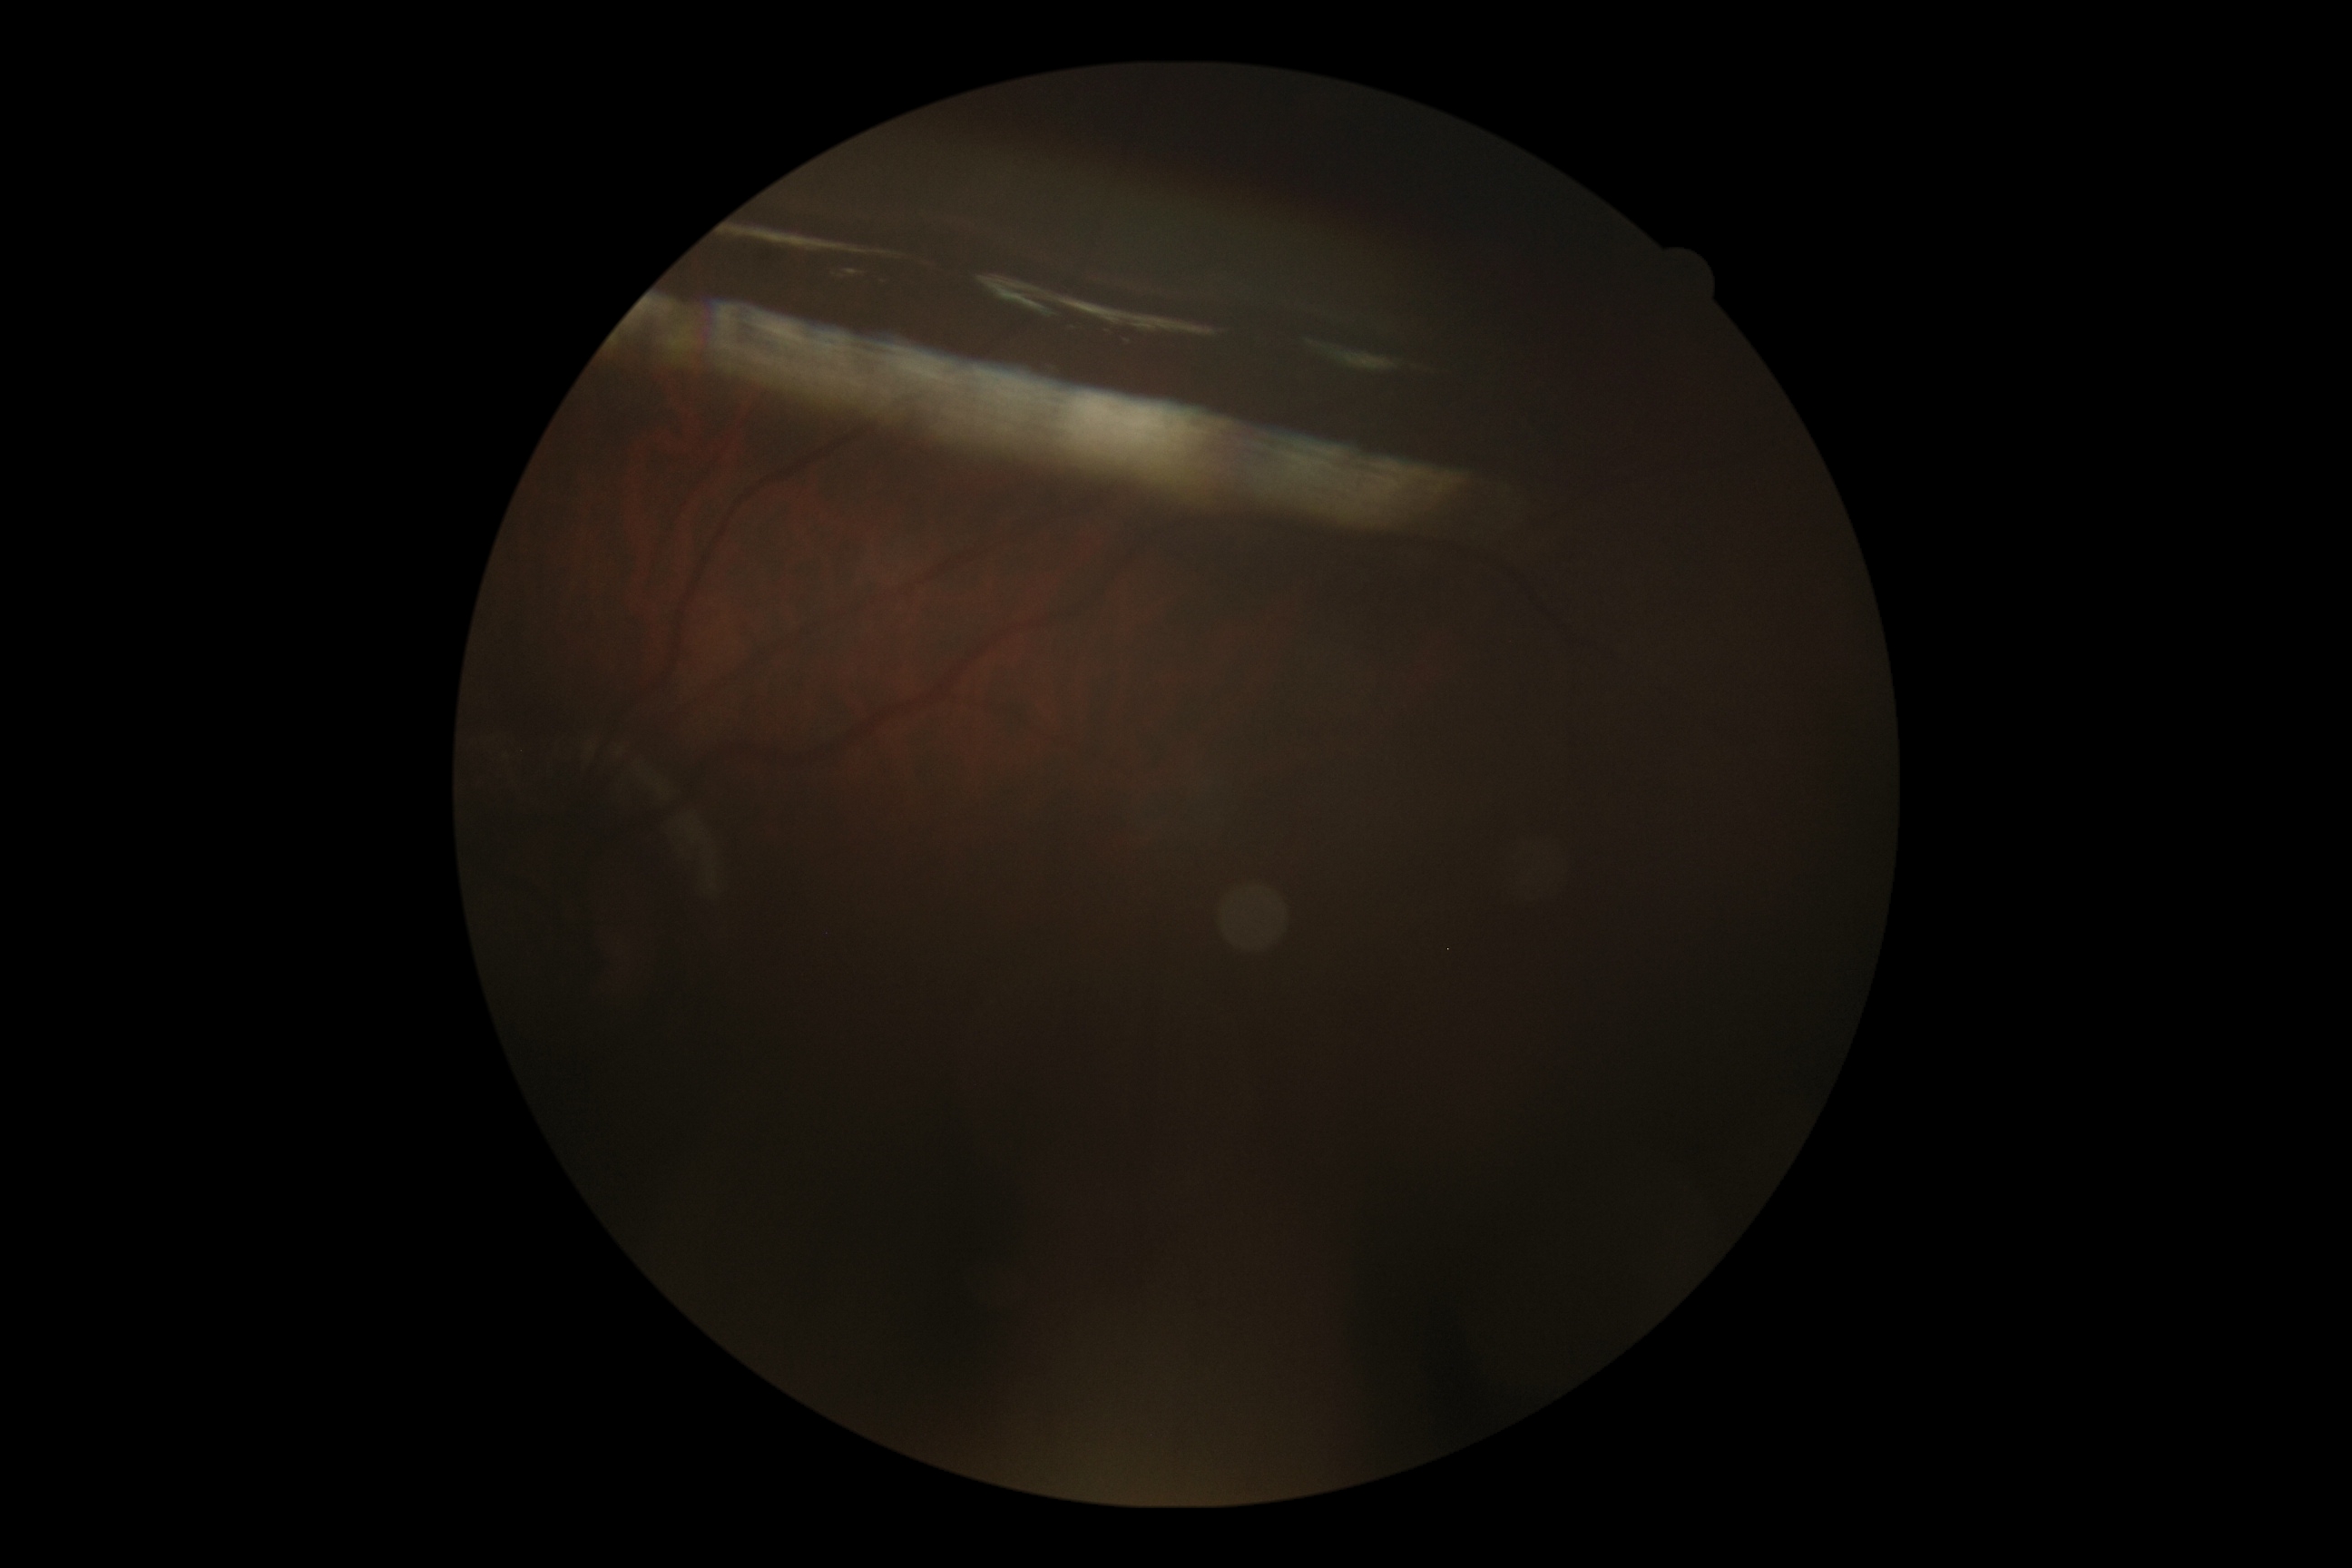

Diabetic retinopathy grade: ungradable due to poor image quality.